45-degree field of view: 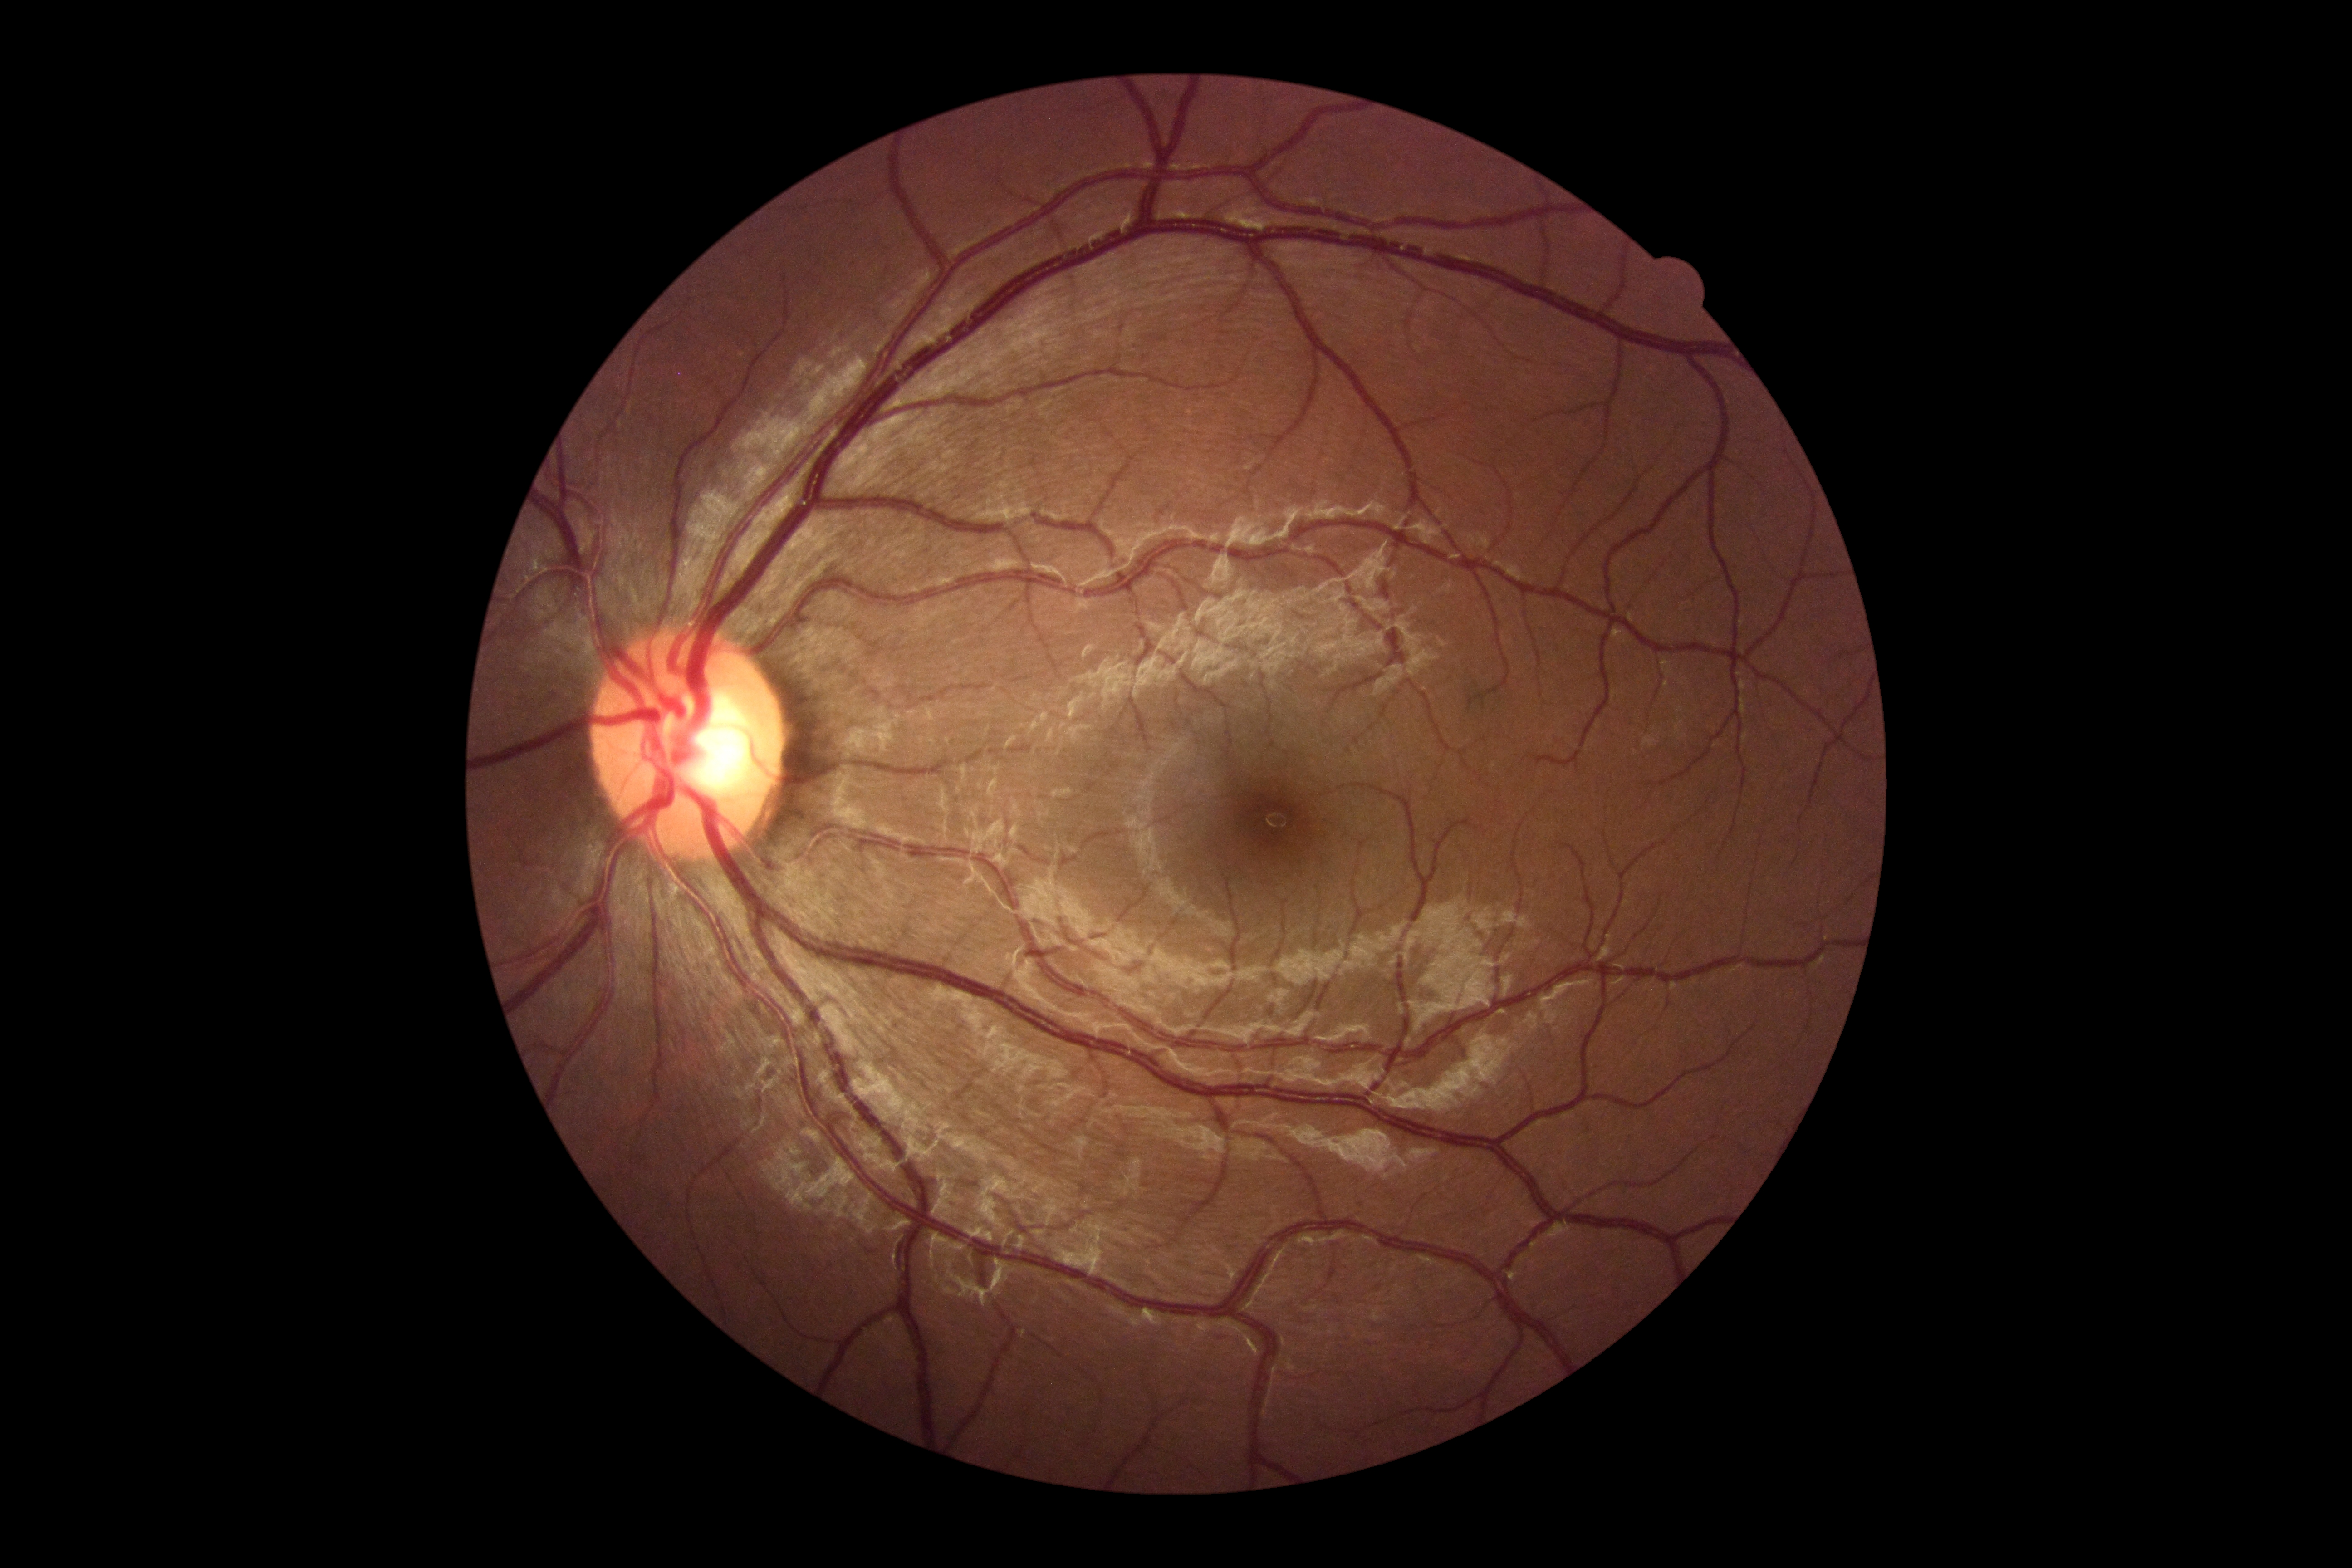

{"dr_grade": "no apparent diabetic retinopathy (grade 0)"}